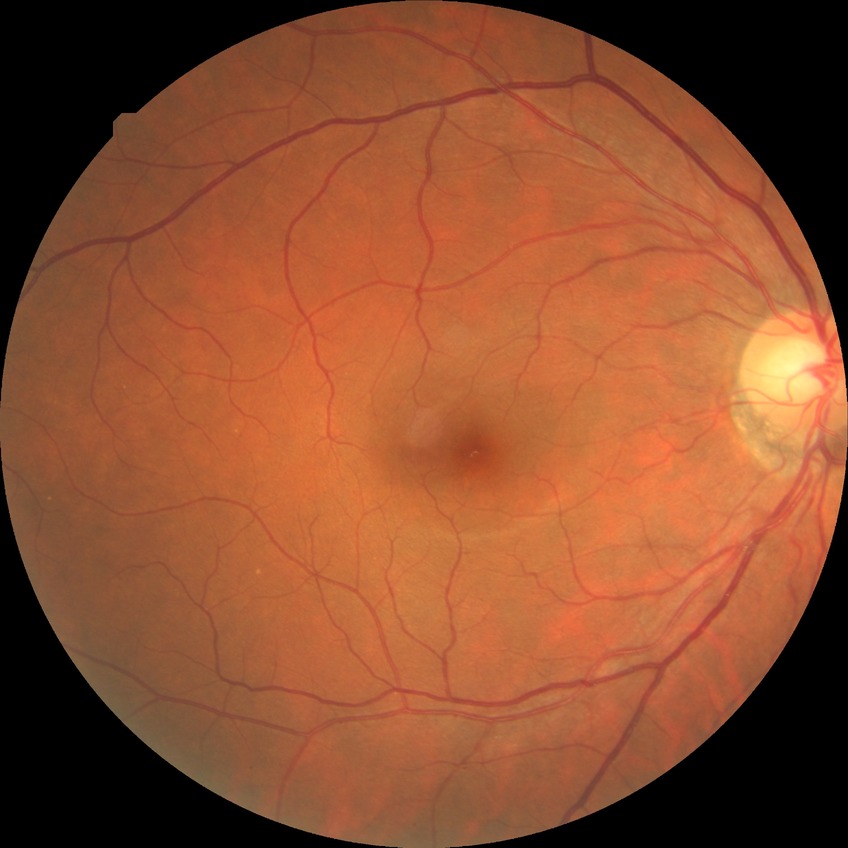
DR grade is SDR.